Optic disc-centered crop from a color fundus photograph
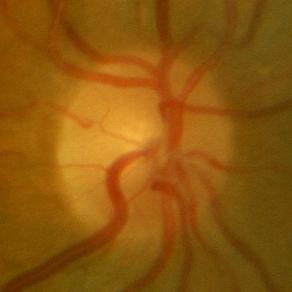
No evidence of glaucoma.